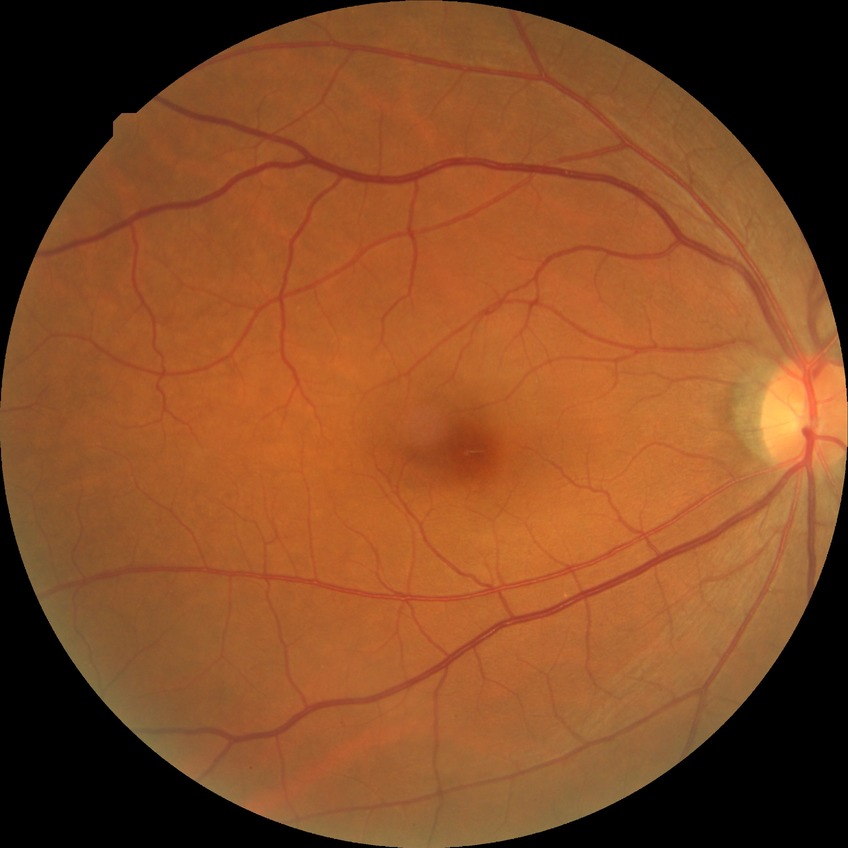 Diabetic retinopathy (DR) is NDR (no diabetic retinopathy).